NIDEK AFC-230 fundus camera; Davis DR grading.
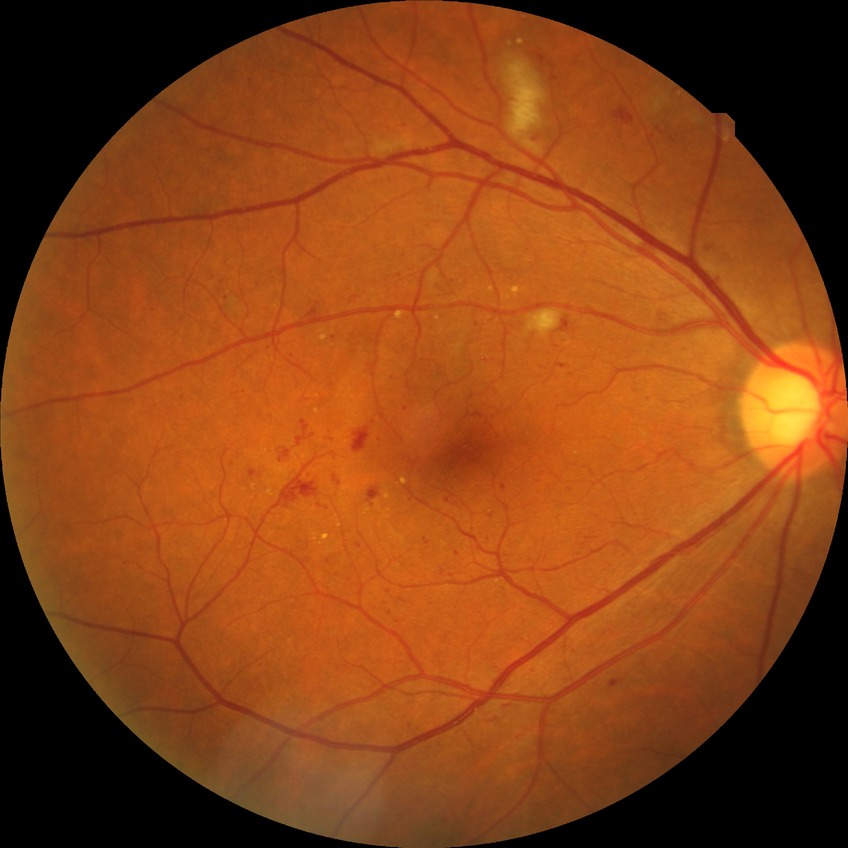 Modified Davis classification: pre-proliferative diabetic retinopathy.